Autorefraction: +3 -0.5 x 72:
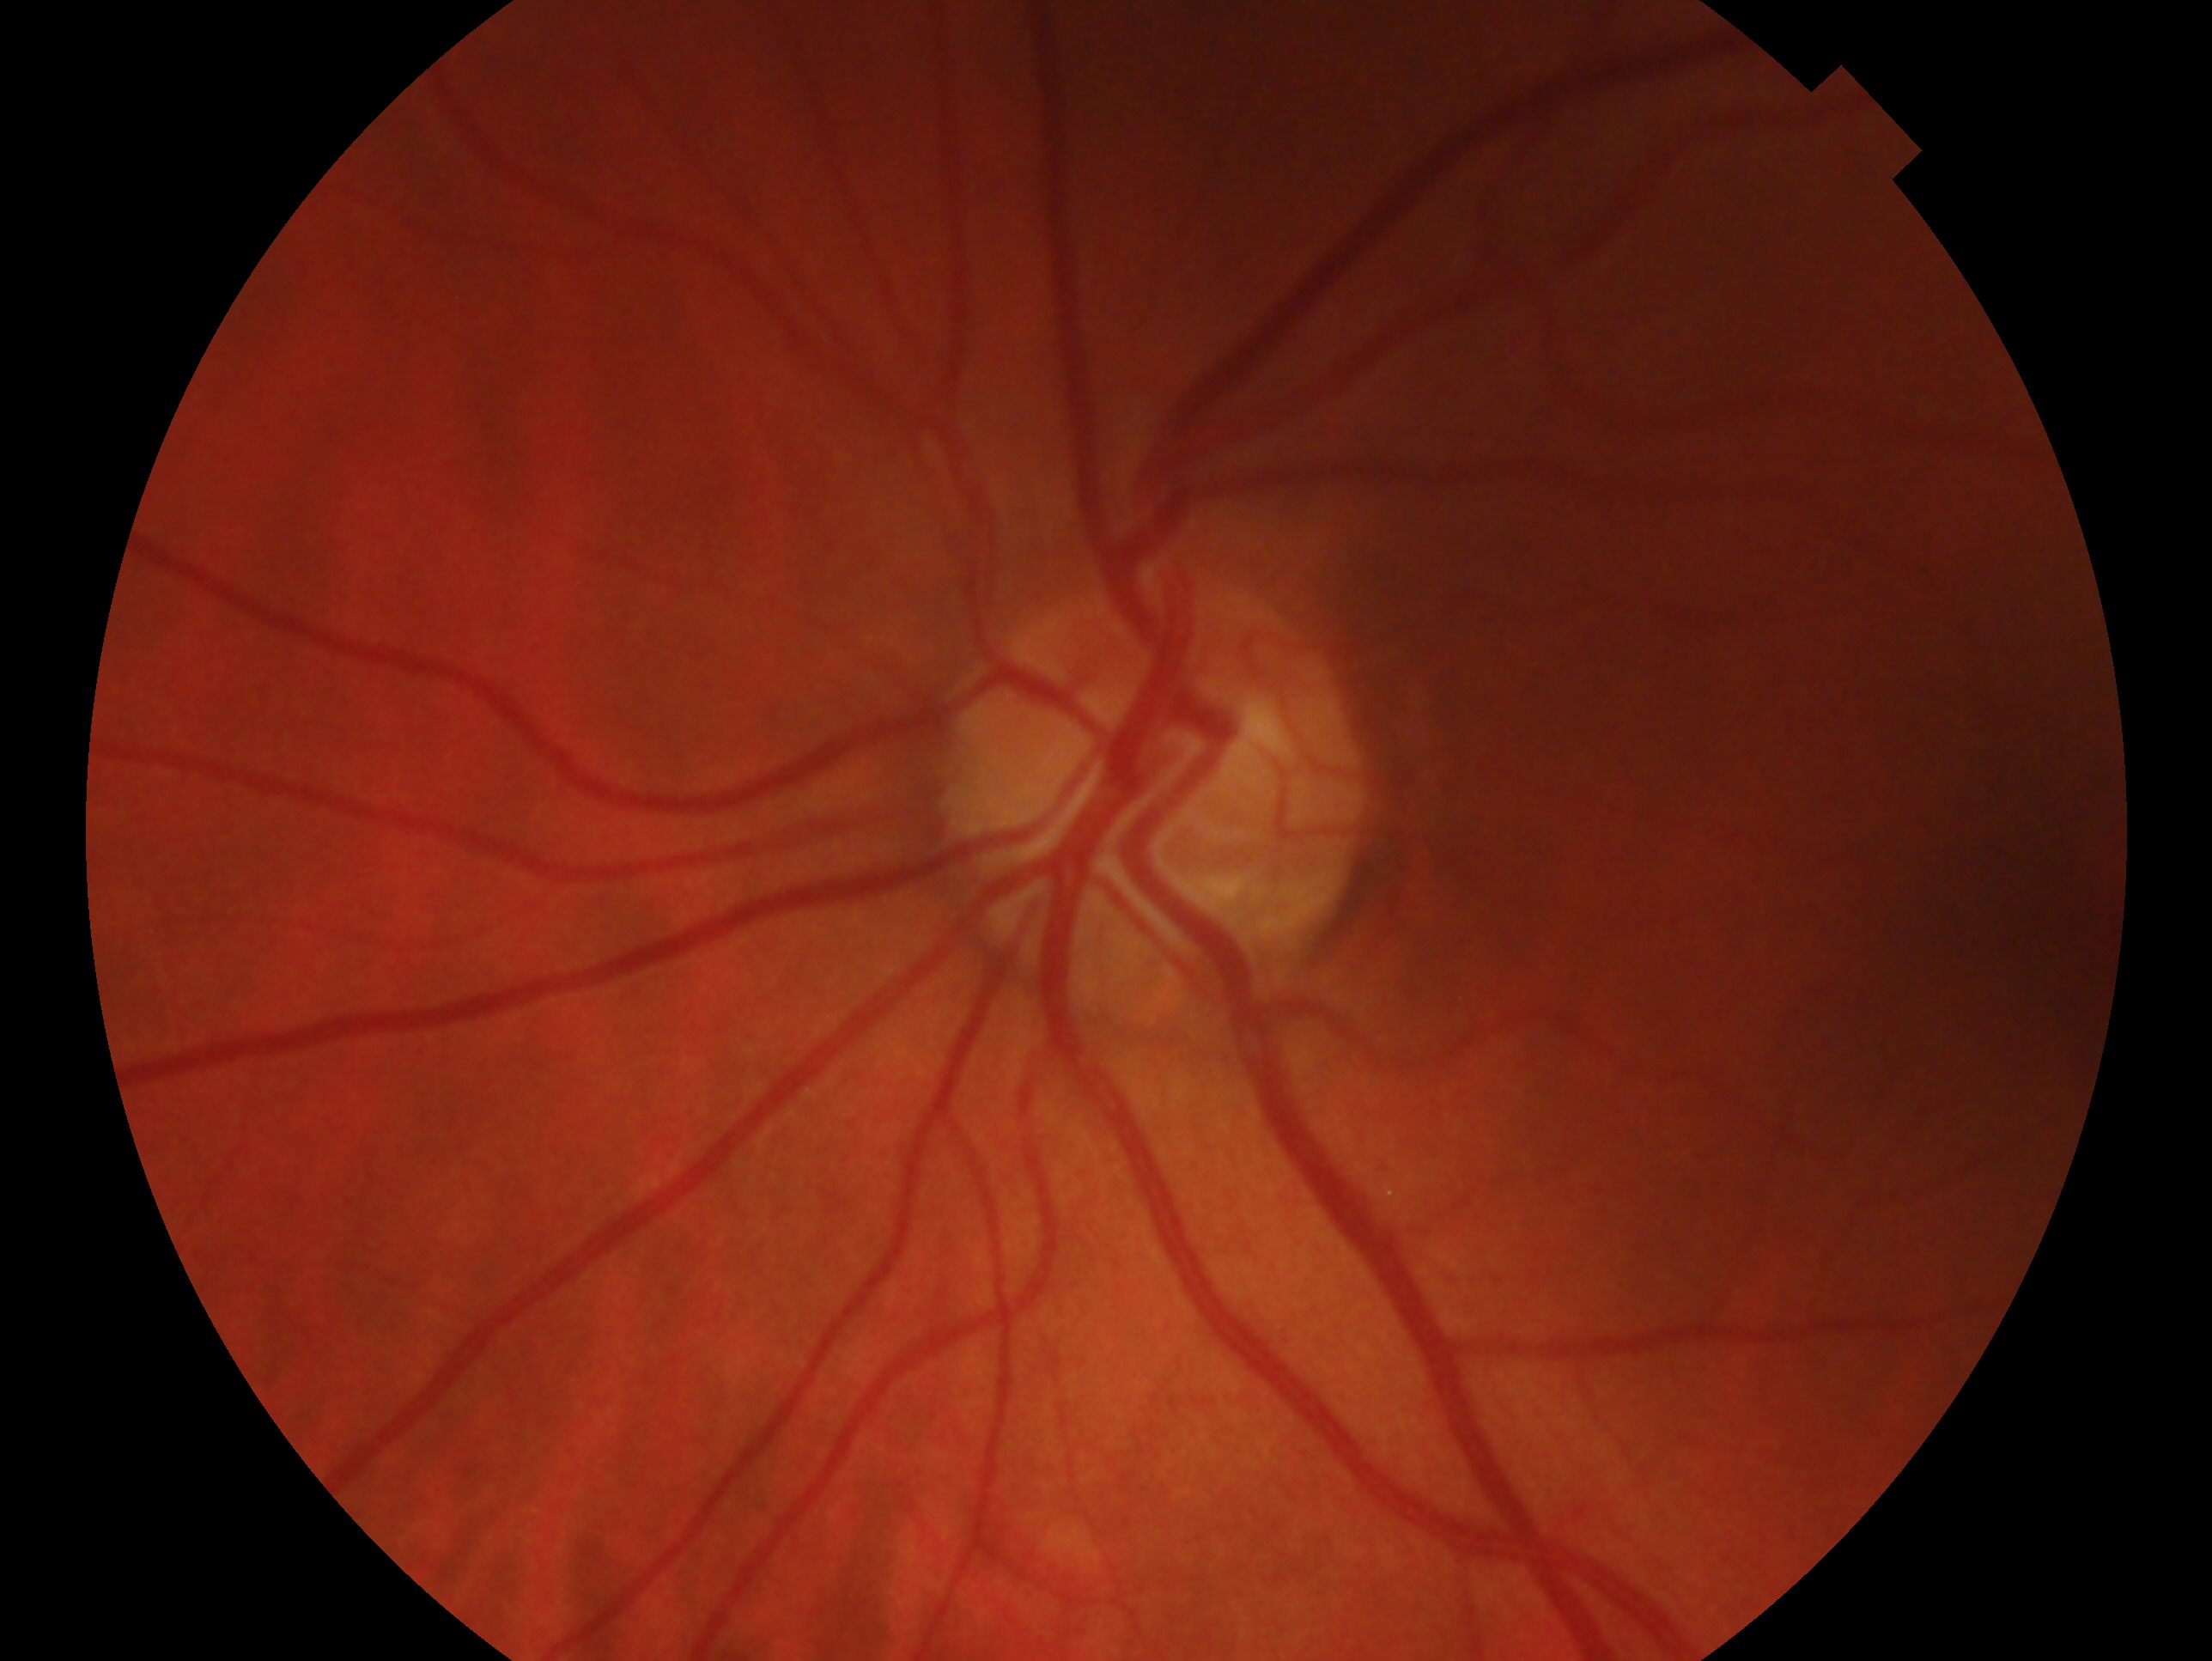
Findings:
– diagnosis: no signs of glaucoma
– laterality: oculus sinister